Disc-centered fundus crop.
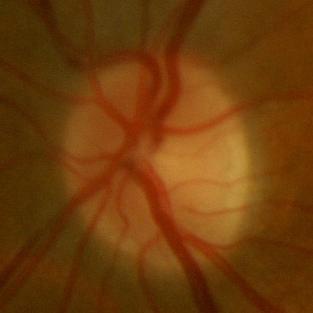
No glaucomatous changes.